CFP · 45° FOV · 1932x1932.
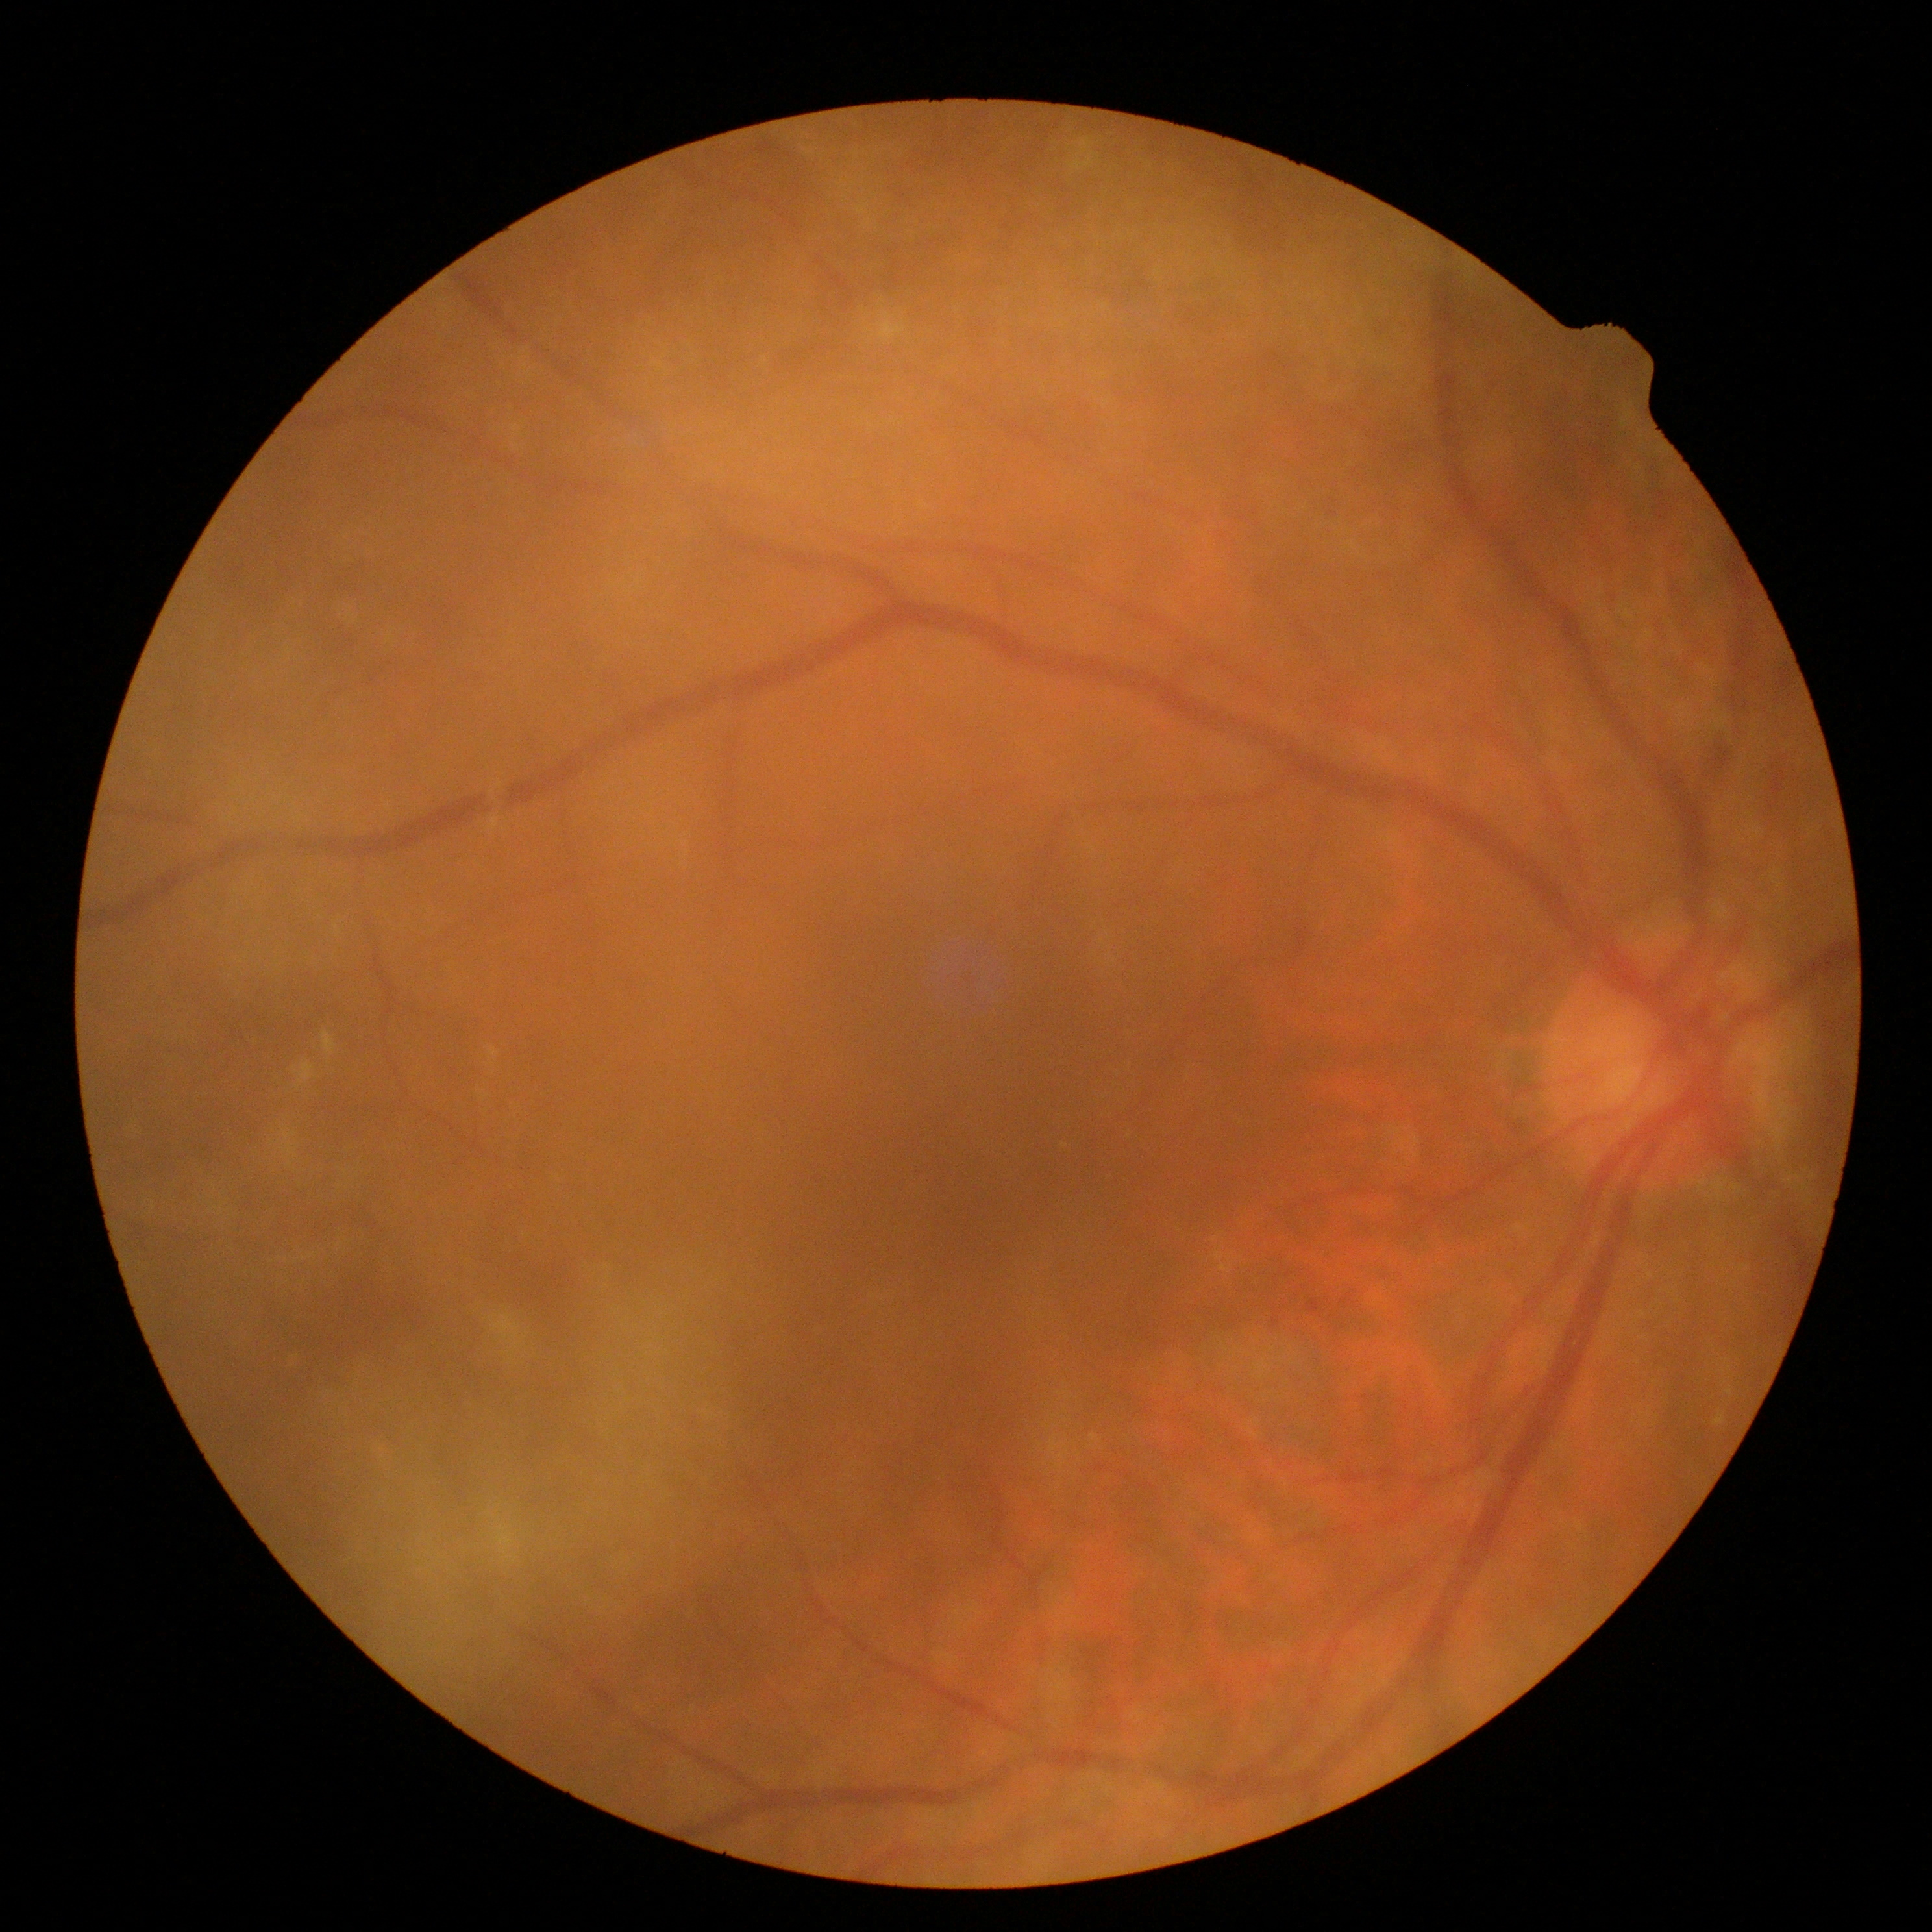

DR is 1. Disease class: non-proliferative diabetic retinopathy.